Portable fundus photograph · 2212 by 1659 pixels.
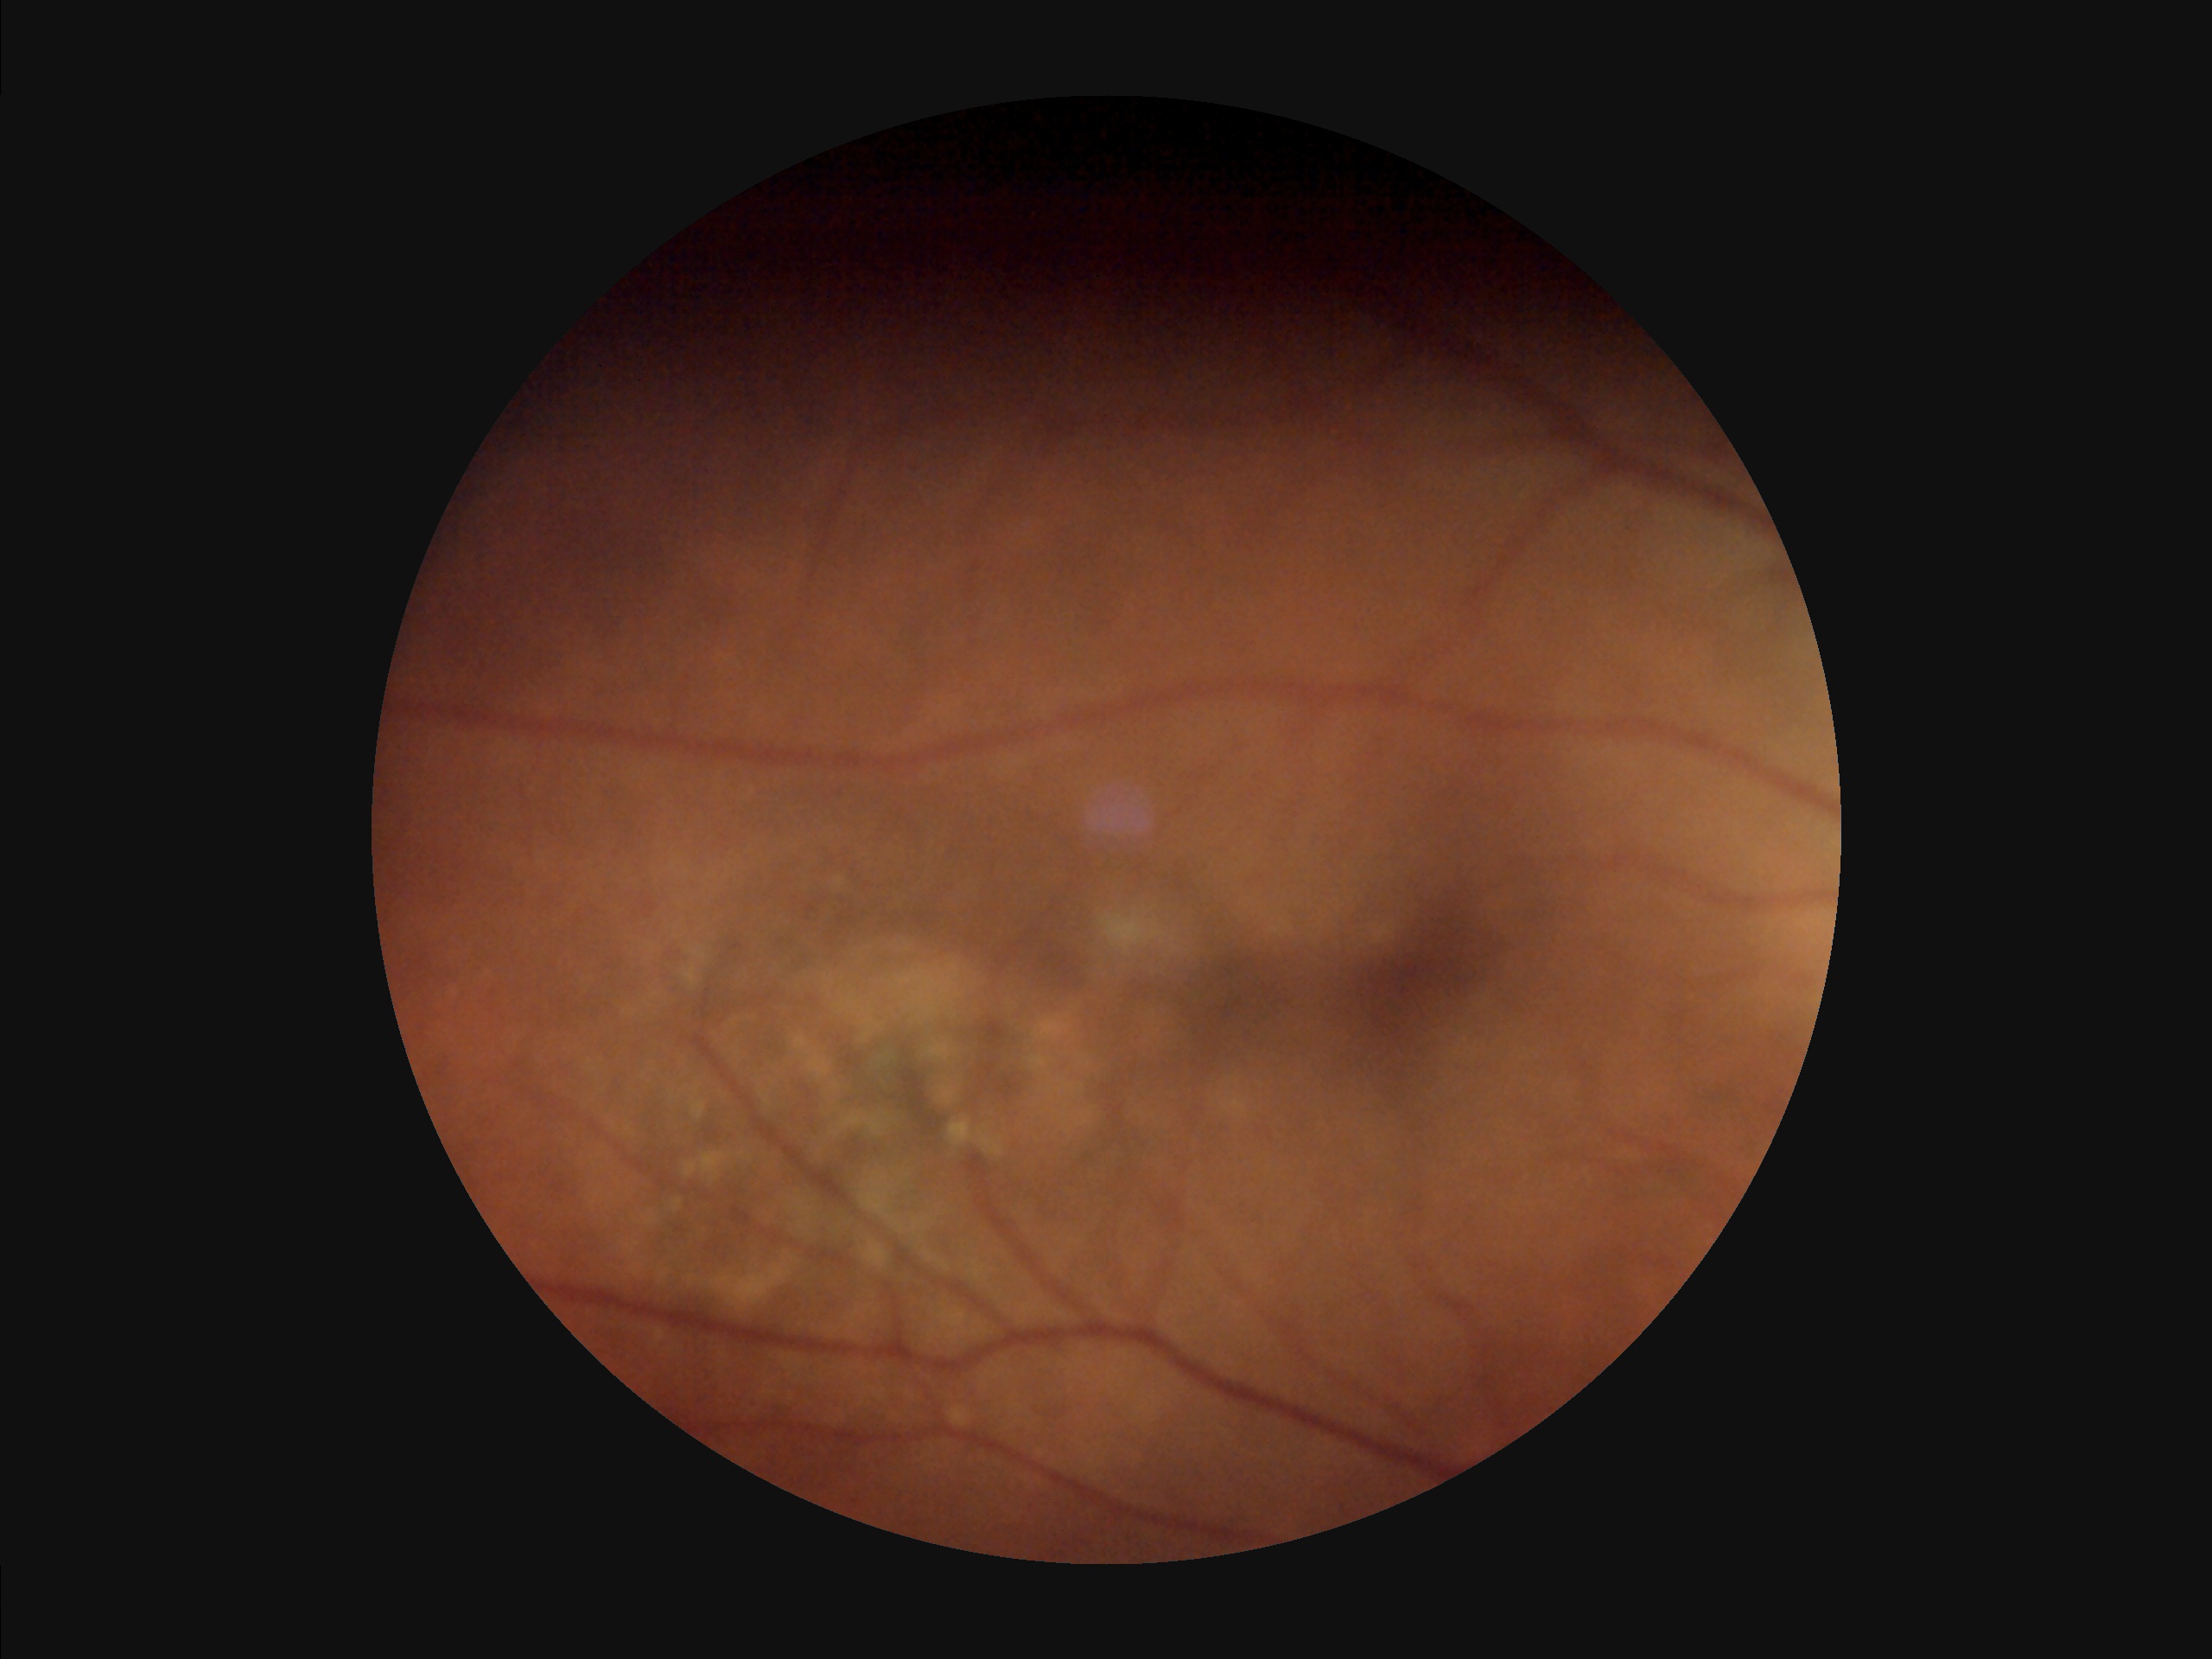
Quality grading:
- contrast: reduced
- clarity: clear
- illumination: suboptimal
- overall: poor